1932x1910px. Color fundus photograph:
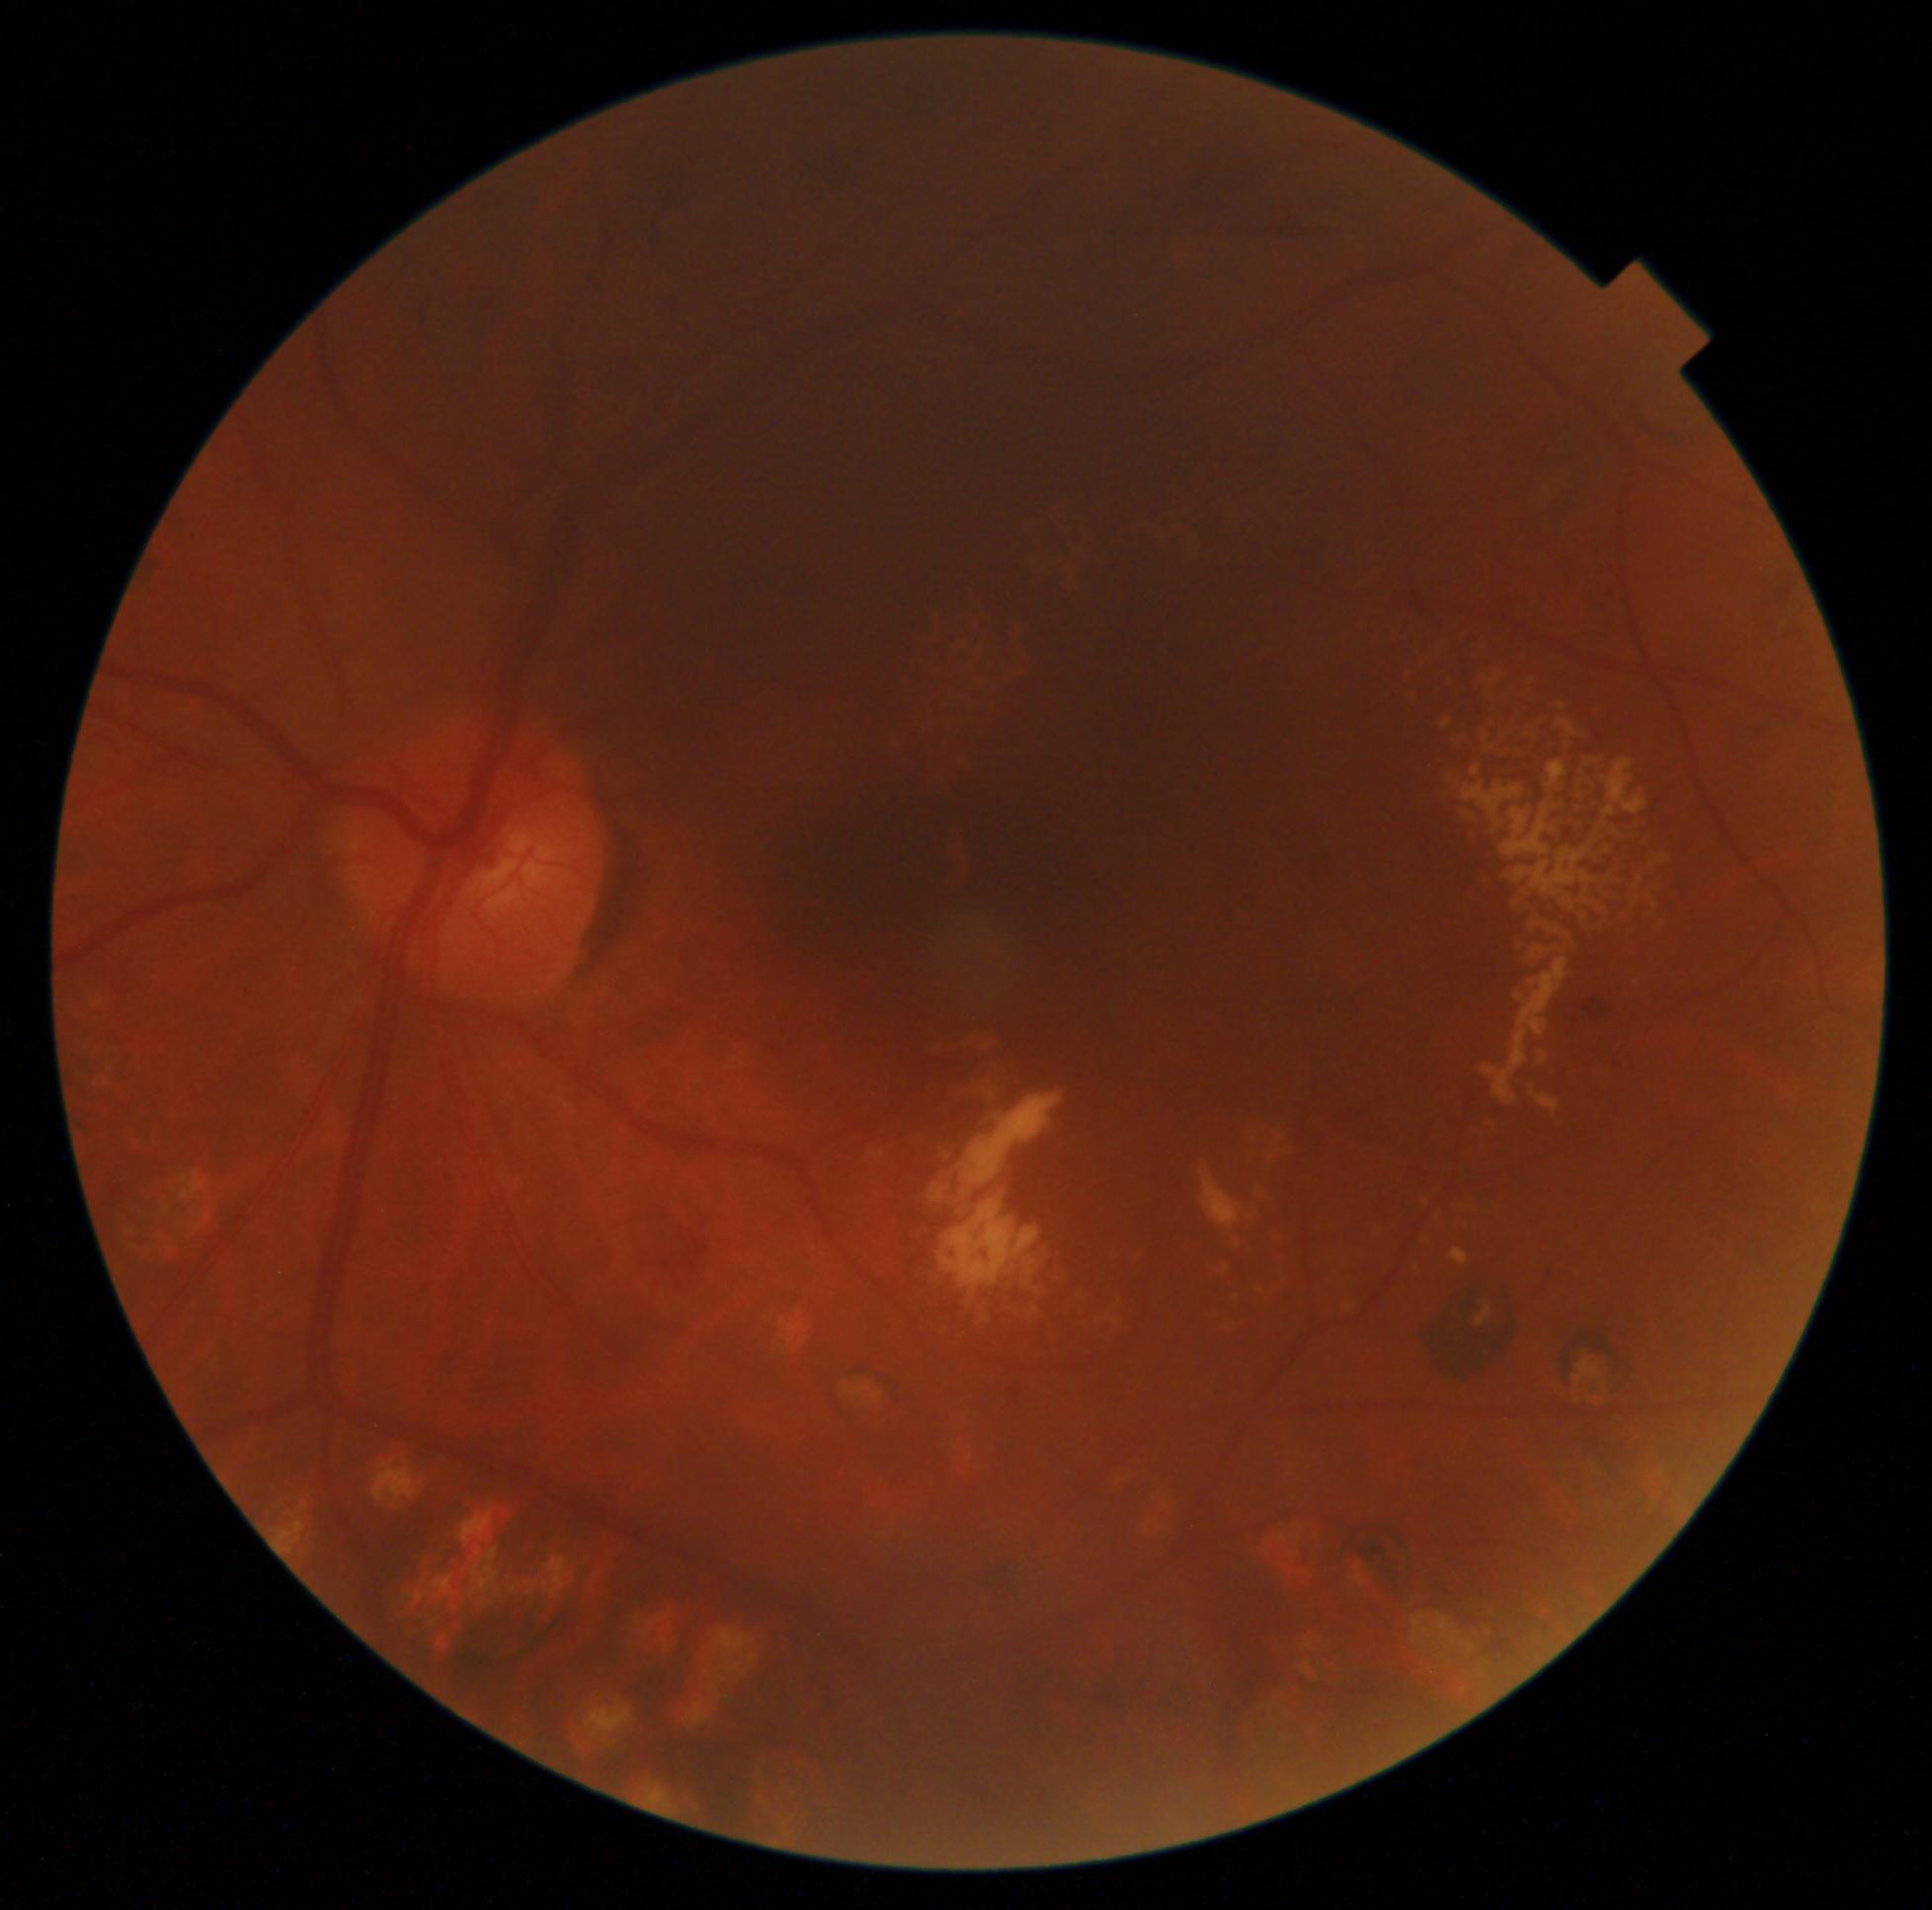 DR is moderate NPDR (grade 2) — more than just microaneurysms but less than severe NPDR.
DR class: non-proliferative diabetic retinopathy.